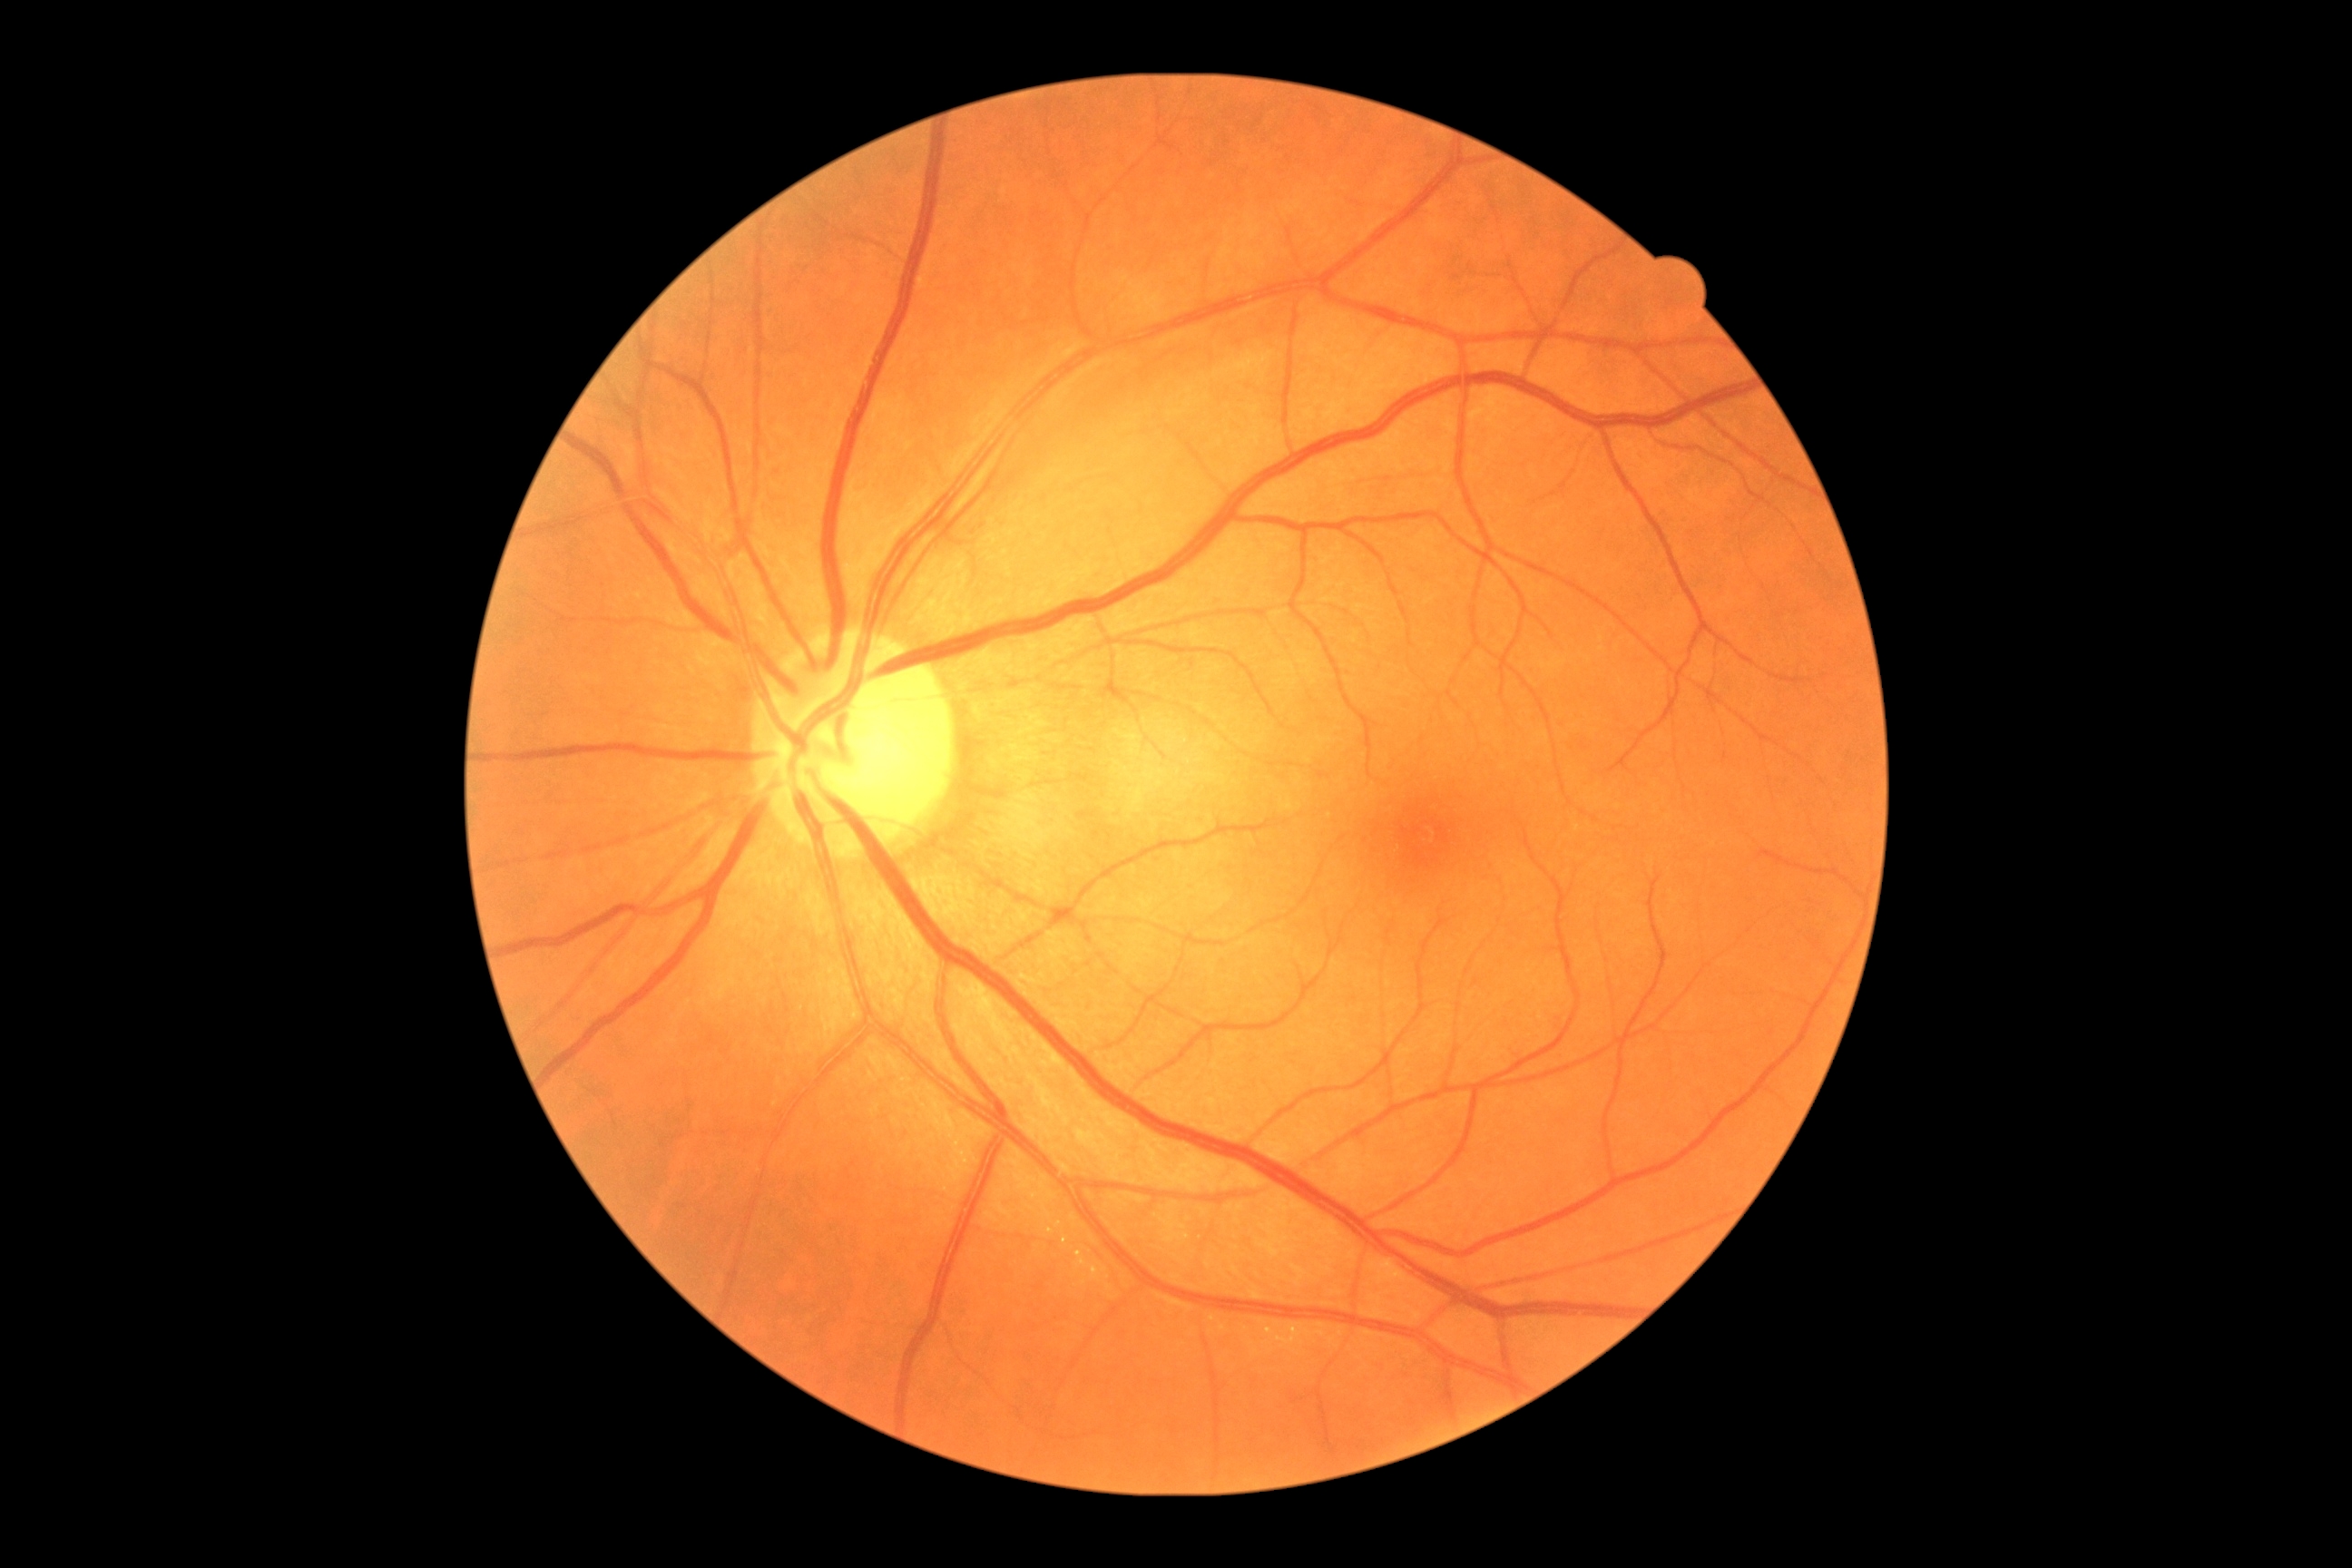

No DR findings.
Diabetic retinopathy is 0/4.